848 by 848 pixels. NIDEK AFC-230 fundus camera. Without pupil dilation
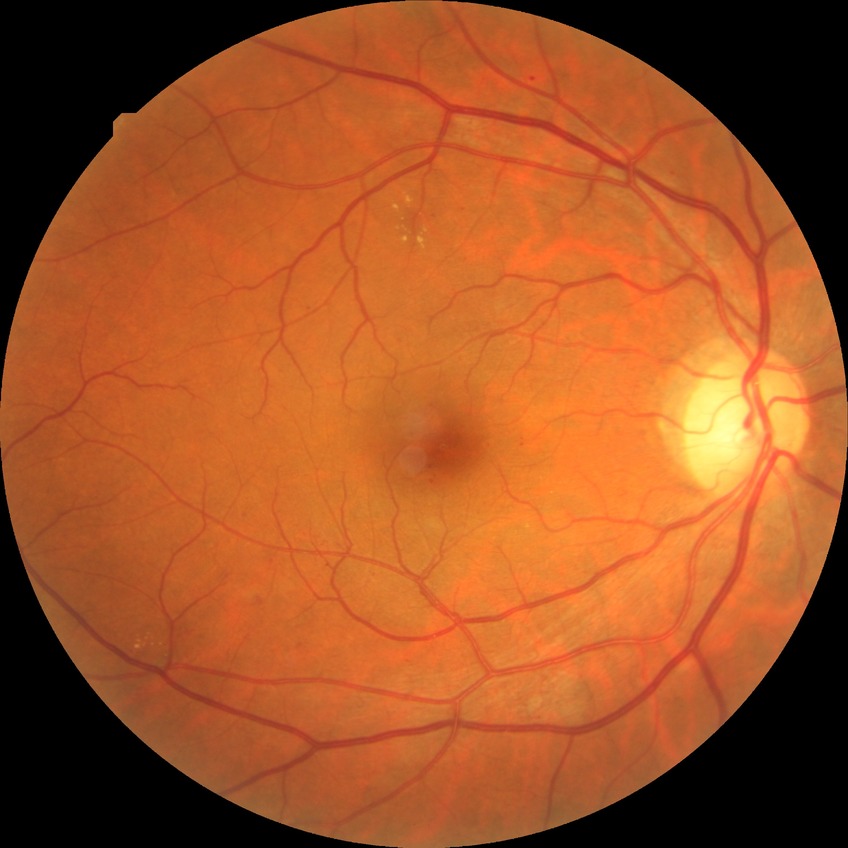
diabetic retinopathy stage=simple diabetic retinopathy.